FOV: 45 degrees: 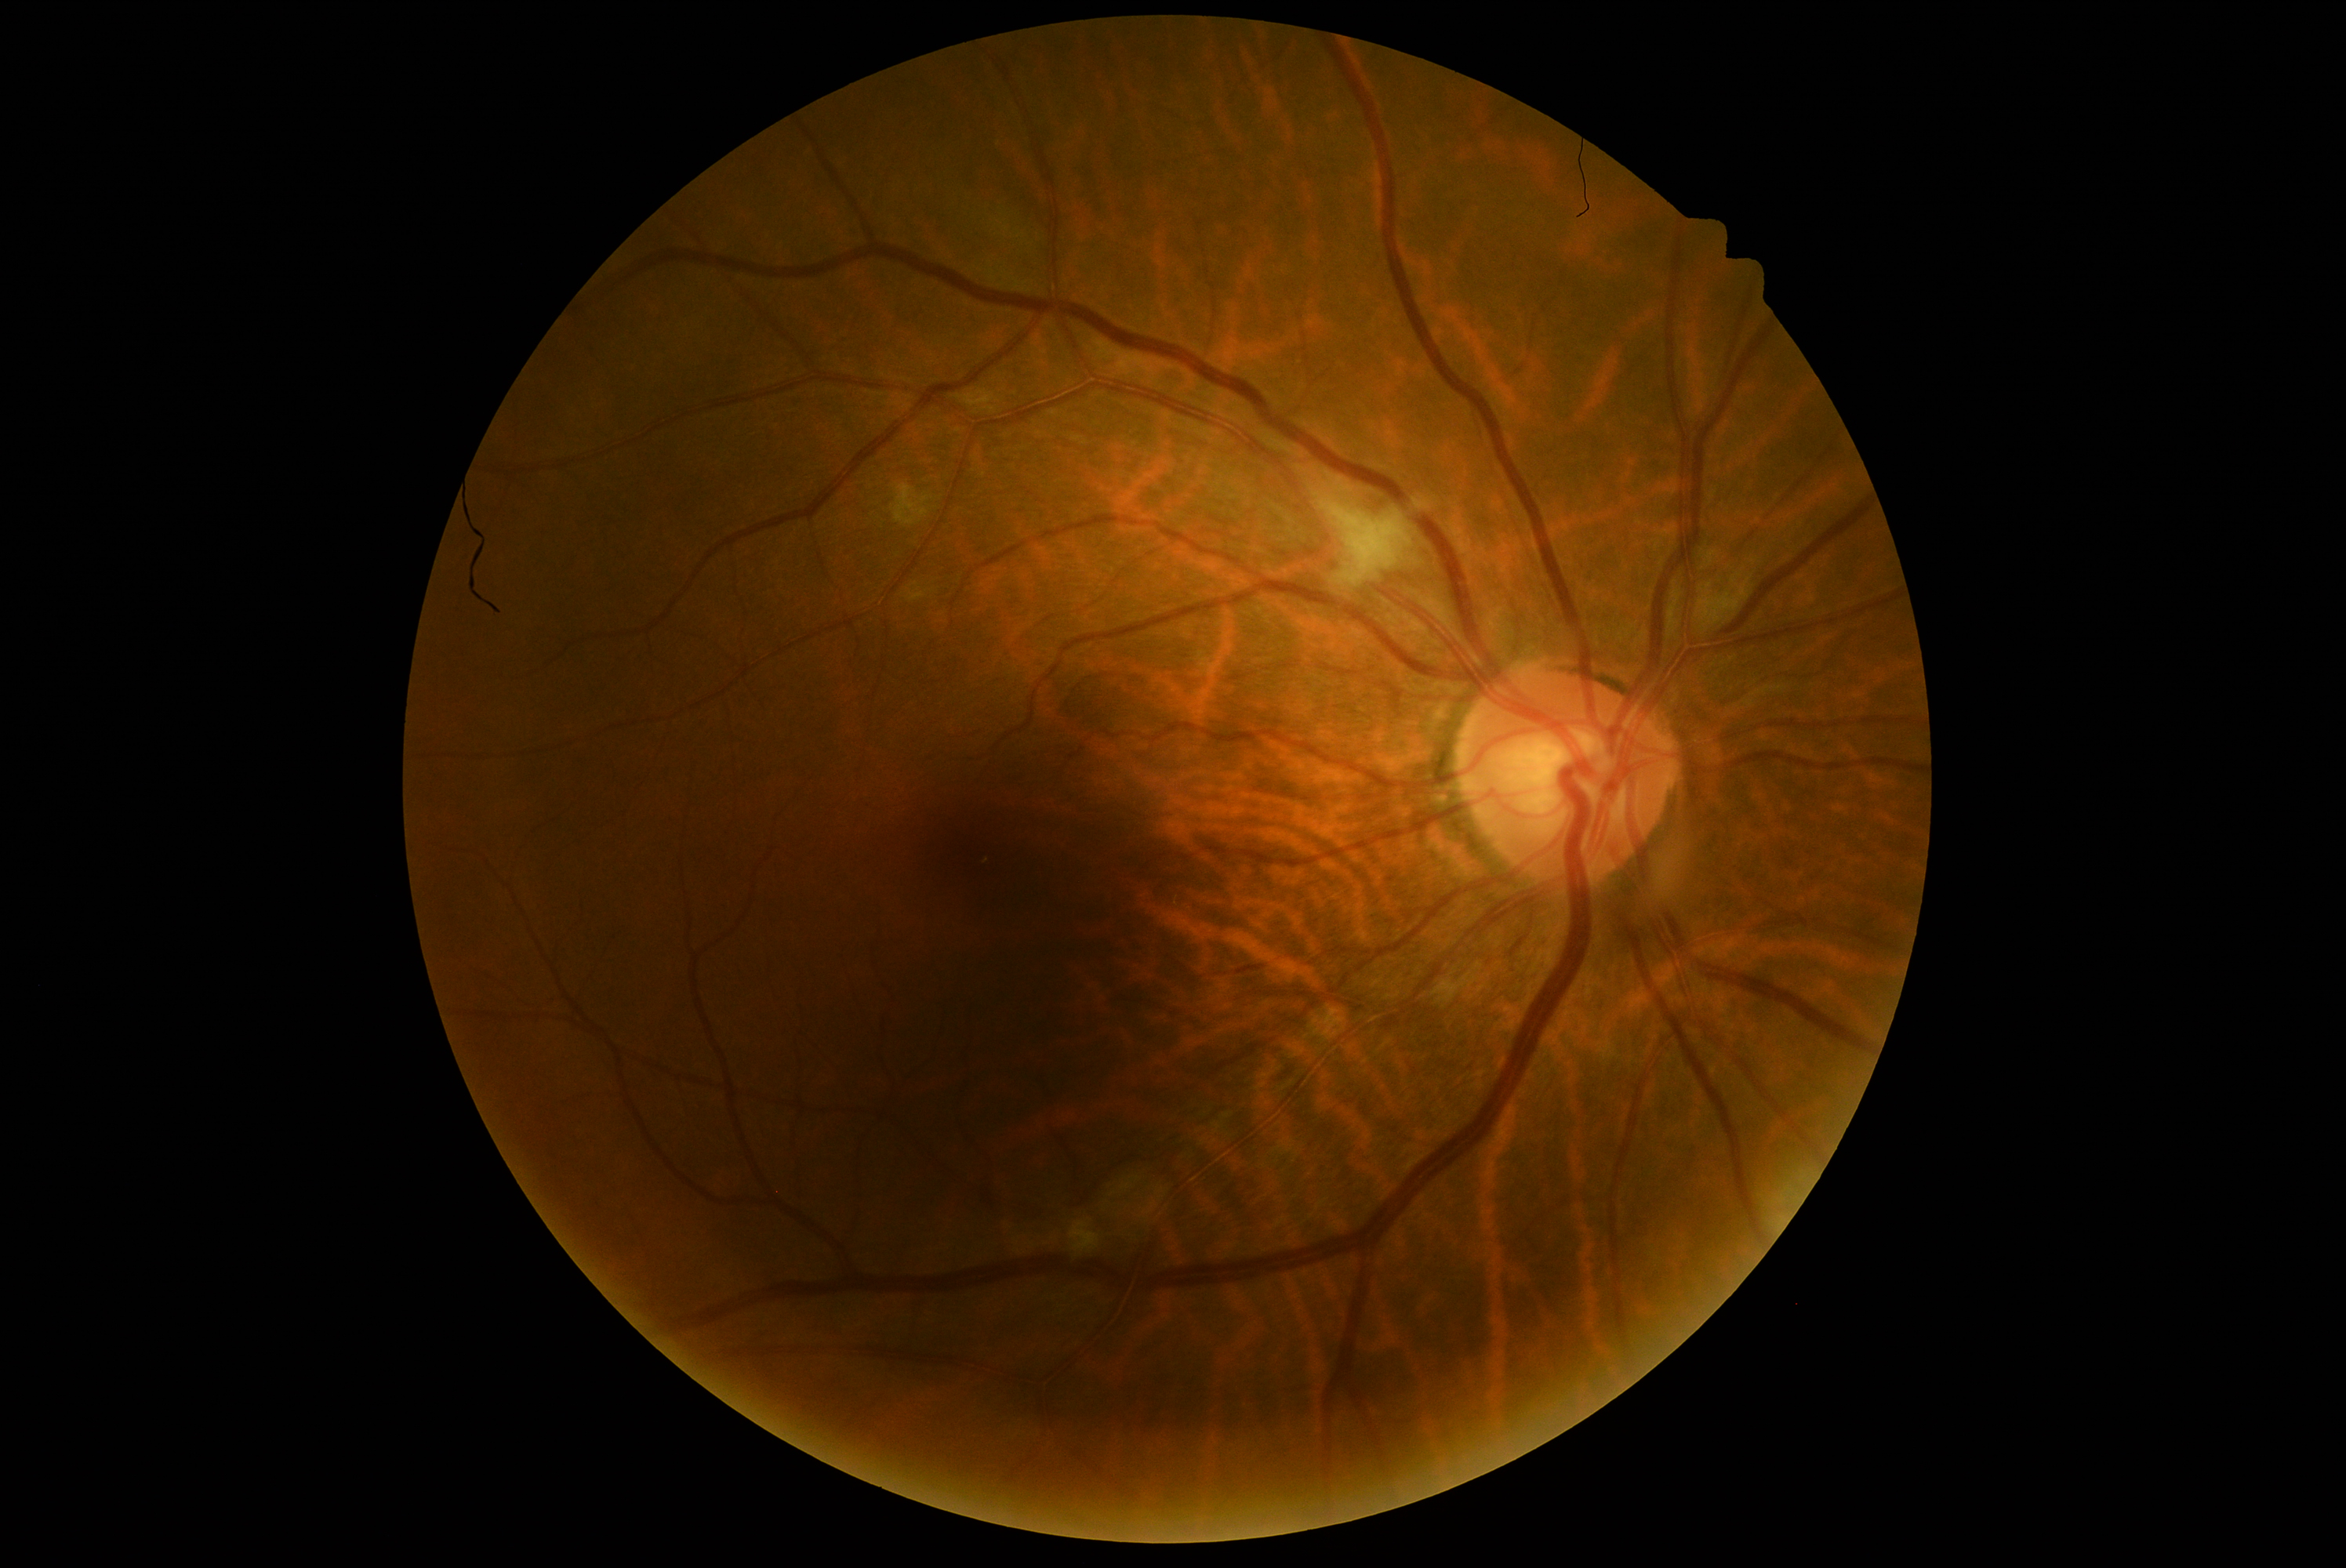
DR class = non-proliferative diabetic retinopathy
DR = moderate non-proliferative diabetic retinopathy (grade 2)